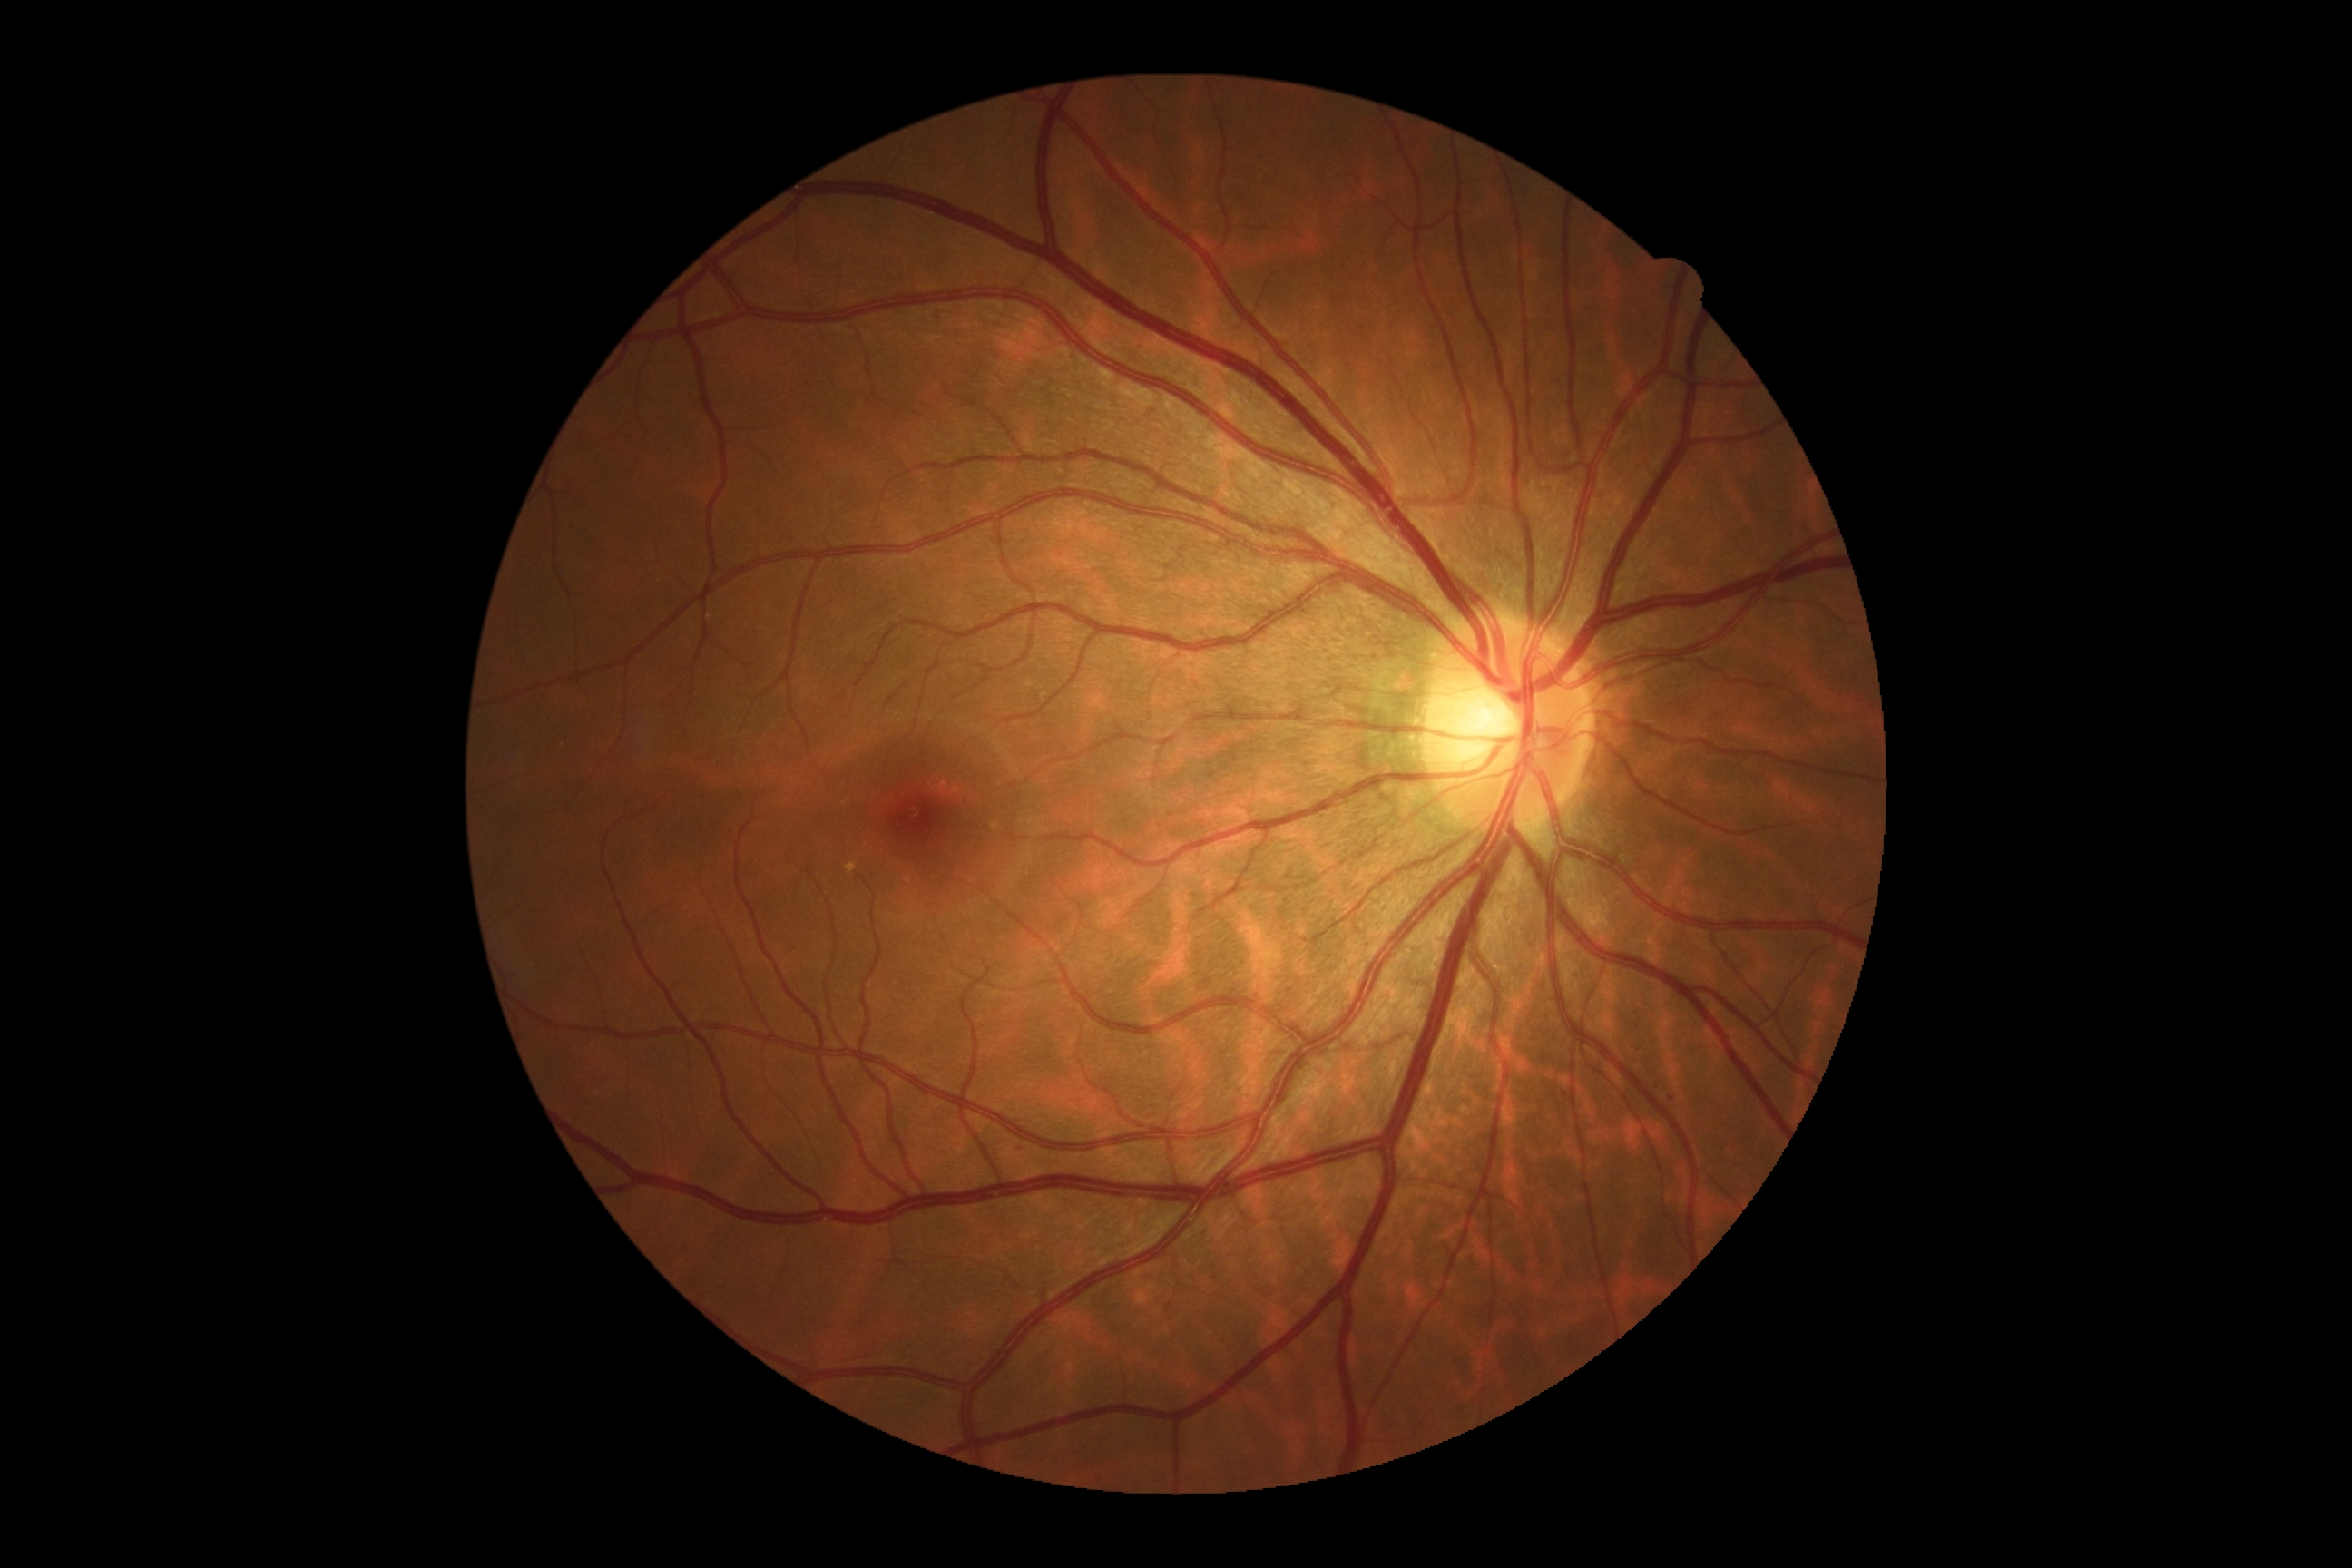
{"dr_impression": "negative for DR", "dr_grade": "no apparent diabetic retinopathy (grade 0)"}